Pediatric wide-field fundus photograph
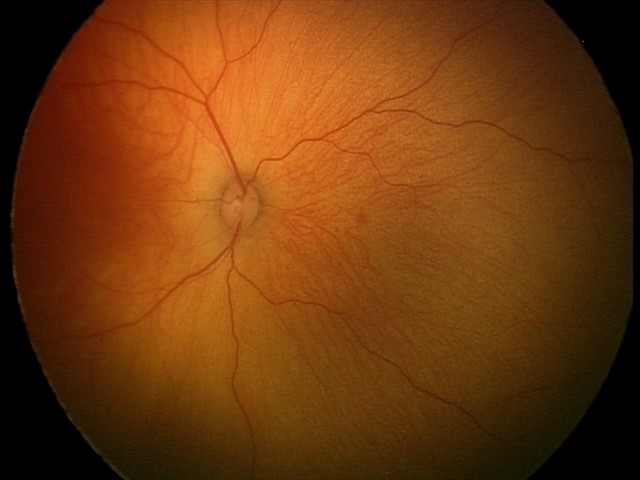 Normal screening examination.